200-degree field of view; UWF retinal mosaic: 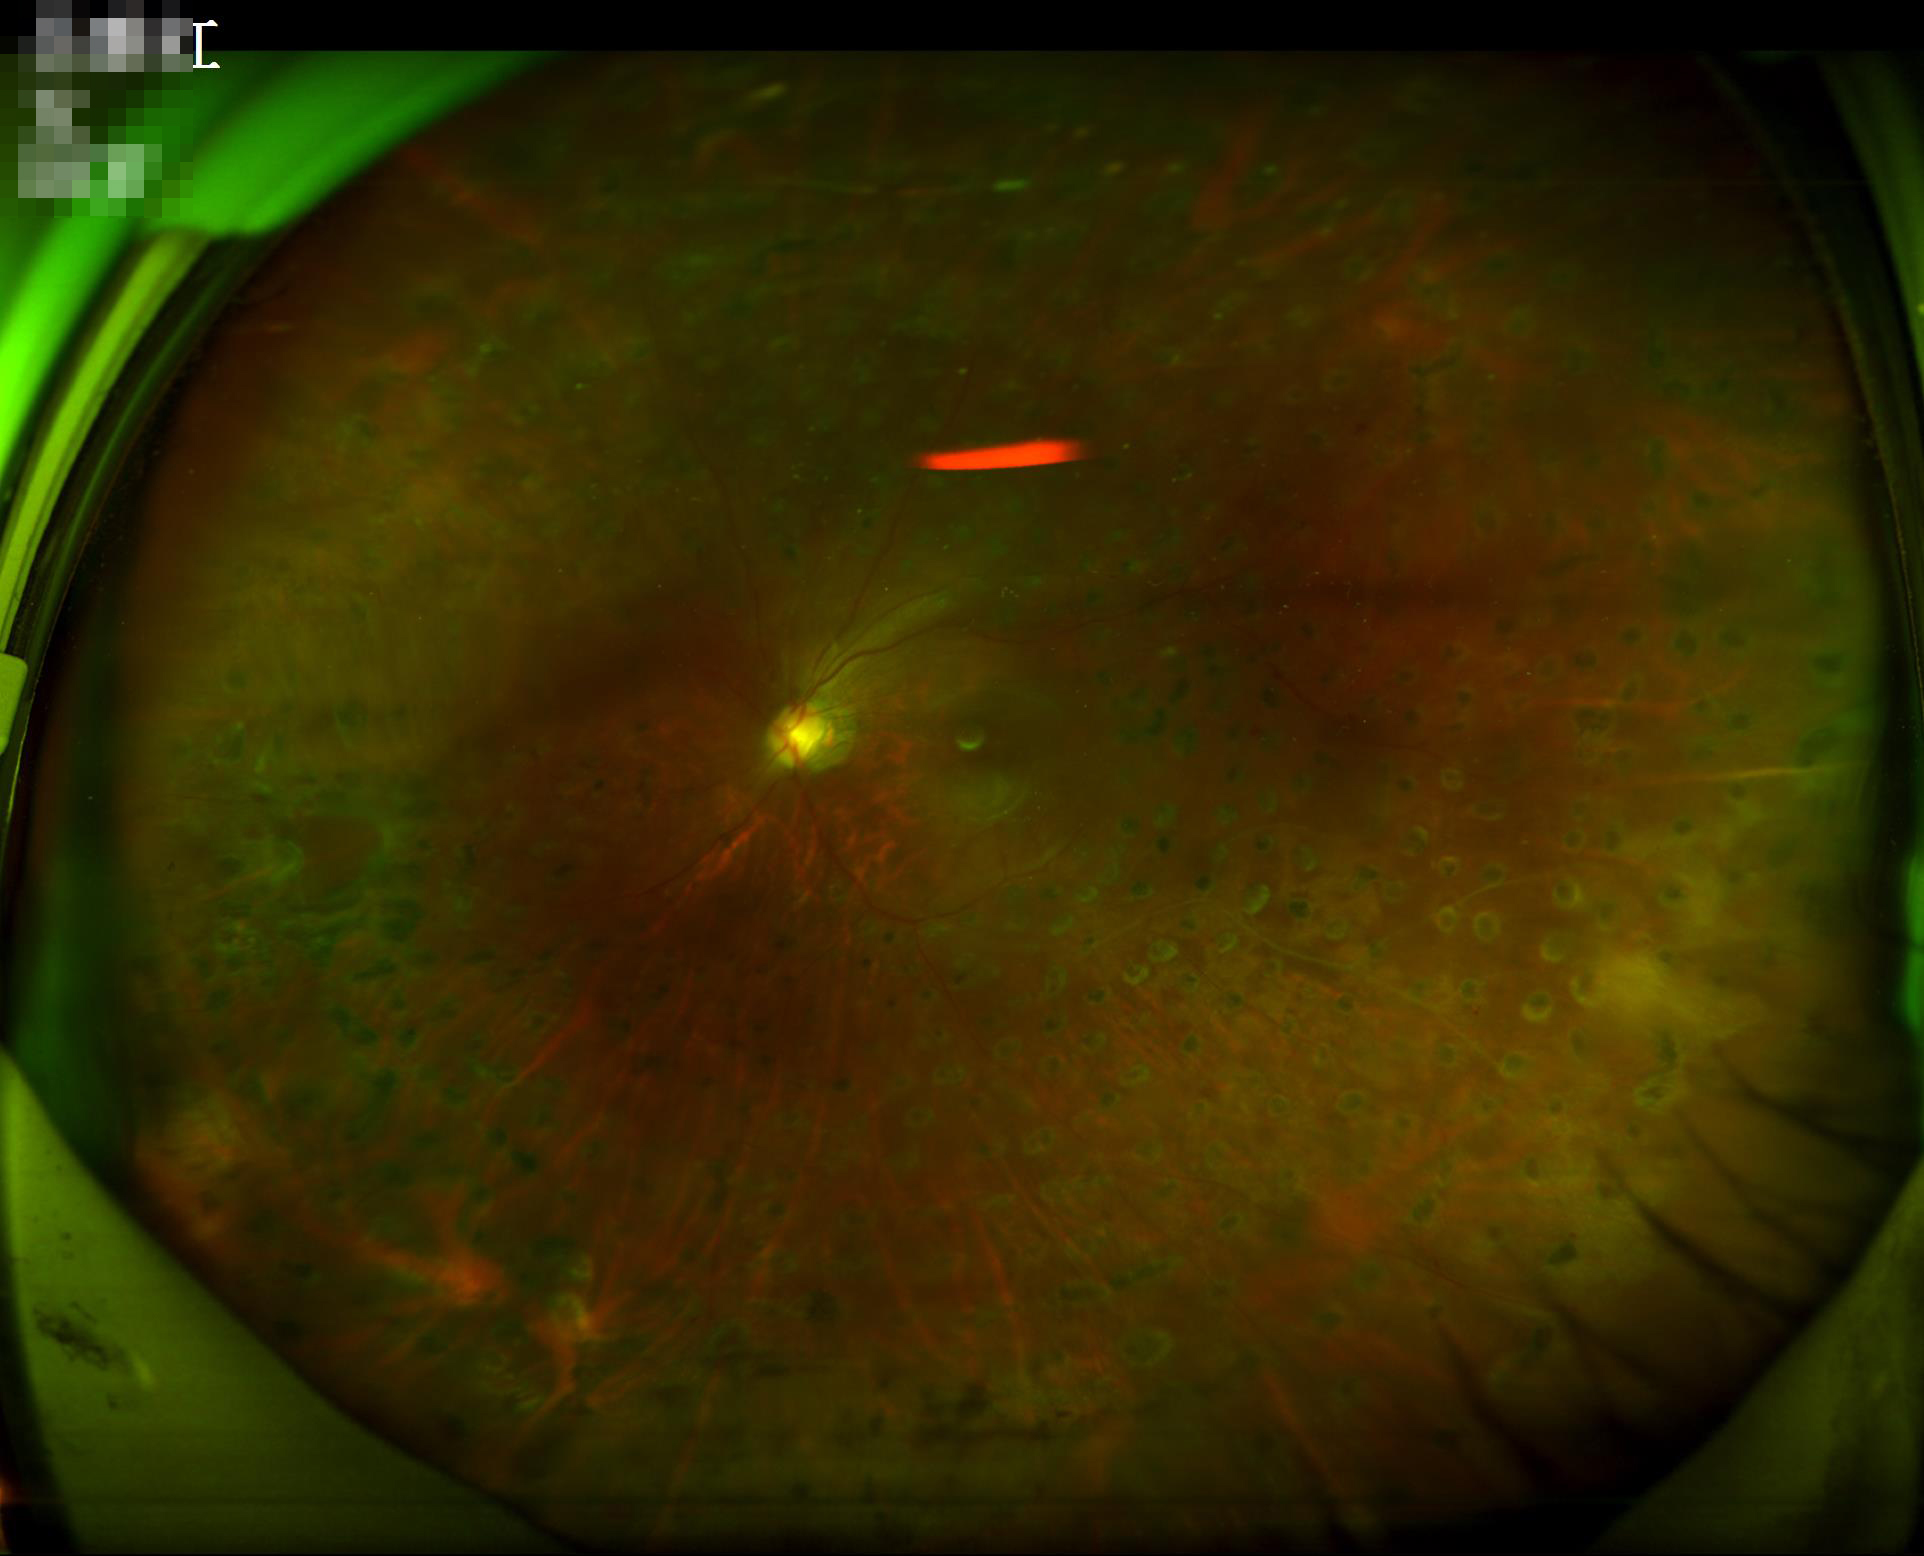 Even illumination with no color cast.
Optic disc, vessels, and background are in focus.
Poor dynamic range.
Overall image quality is poor.